45° FOV: 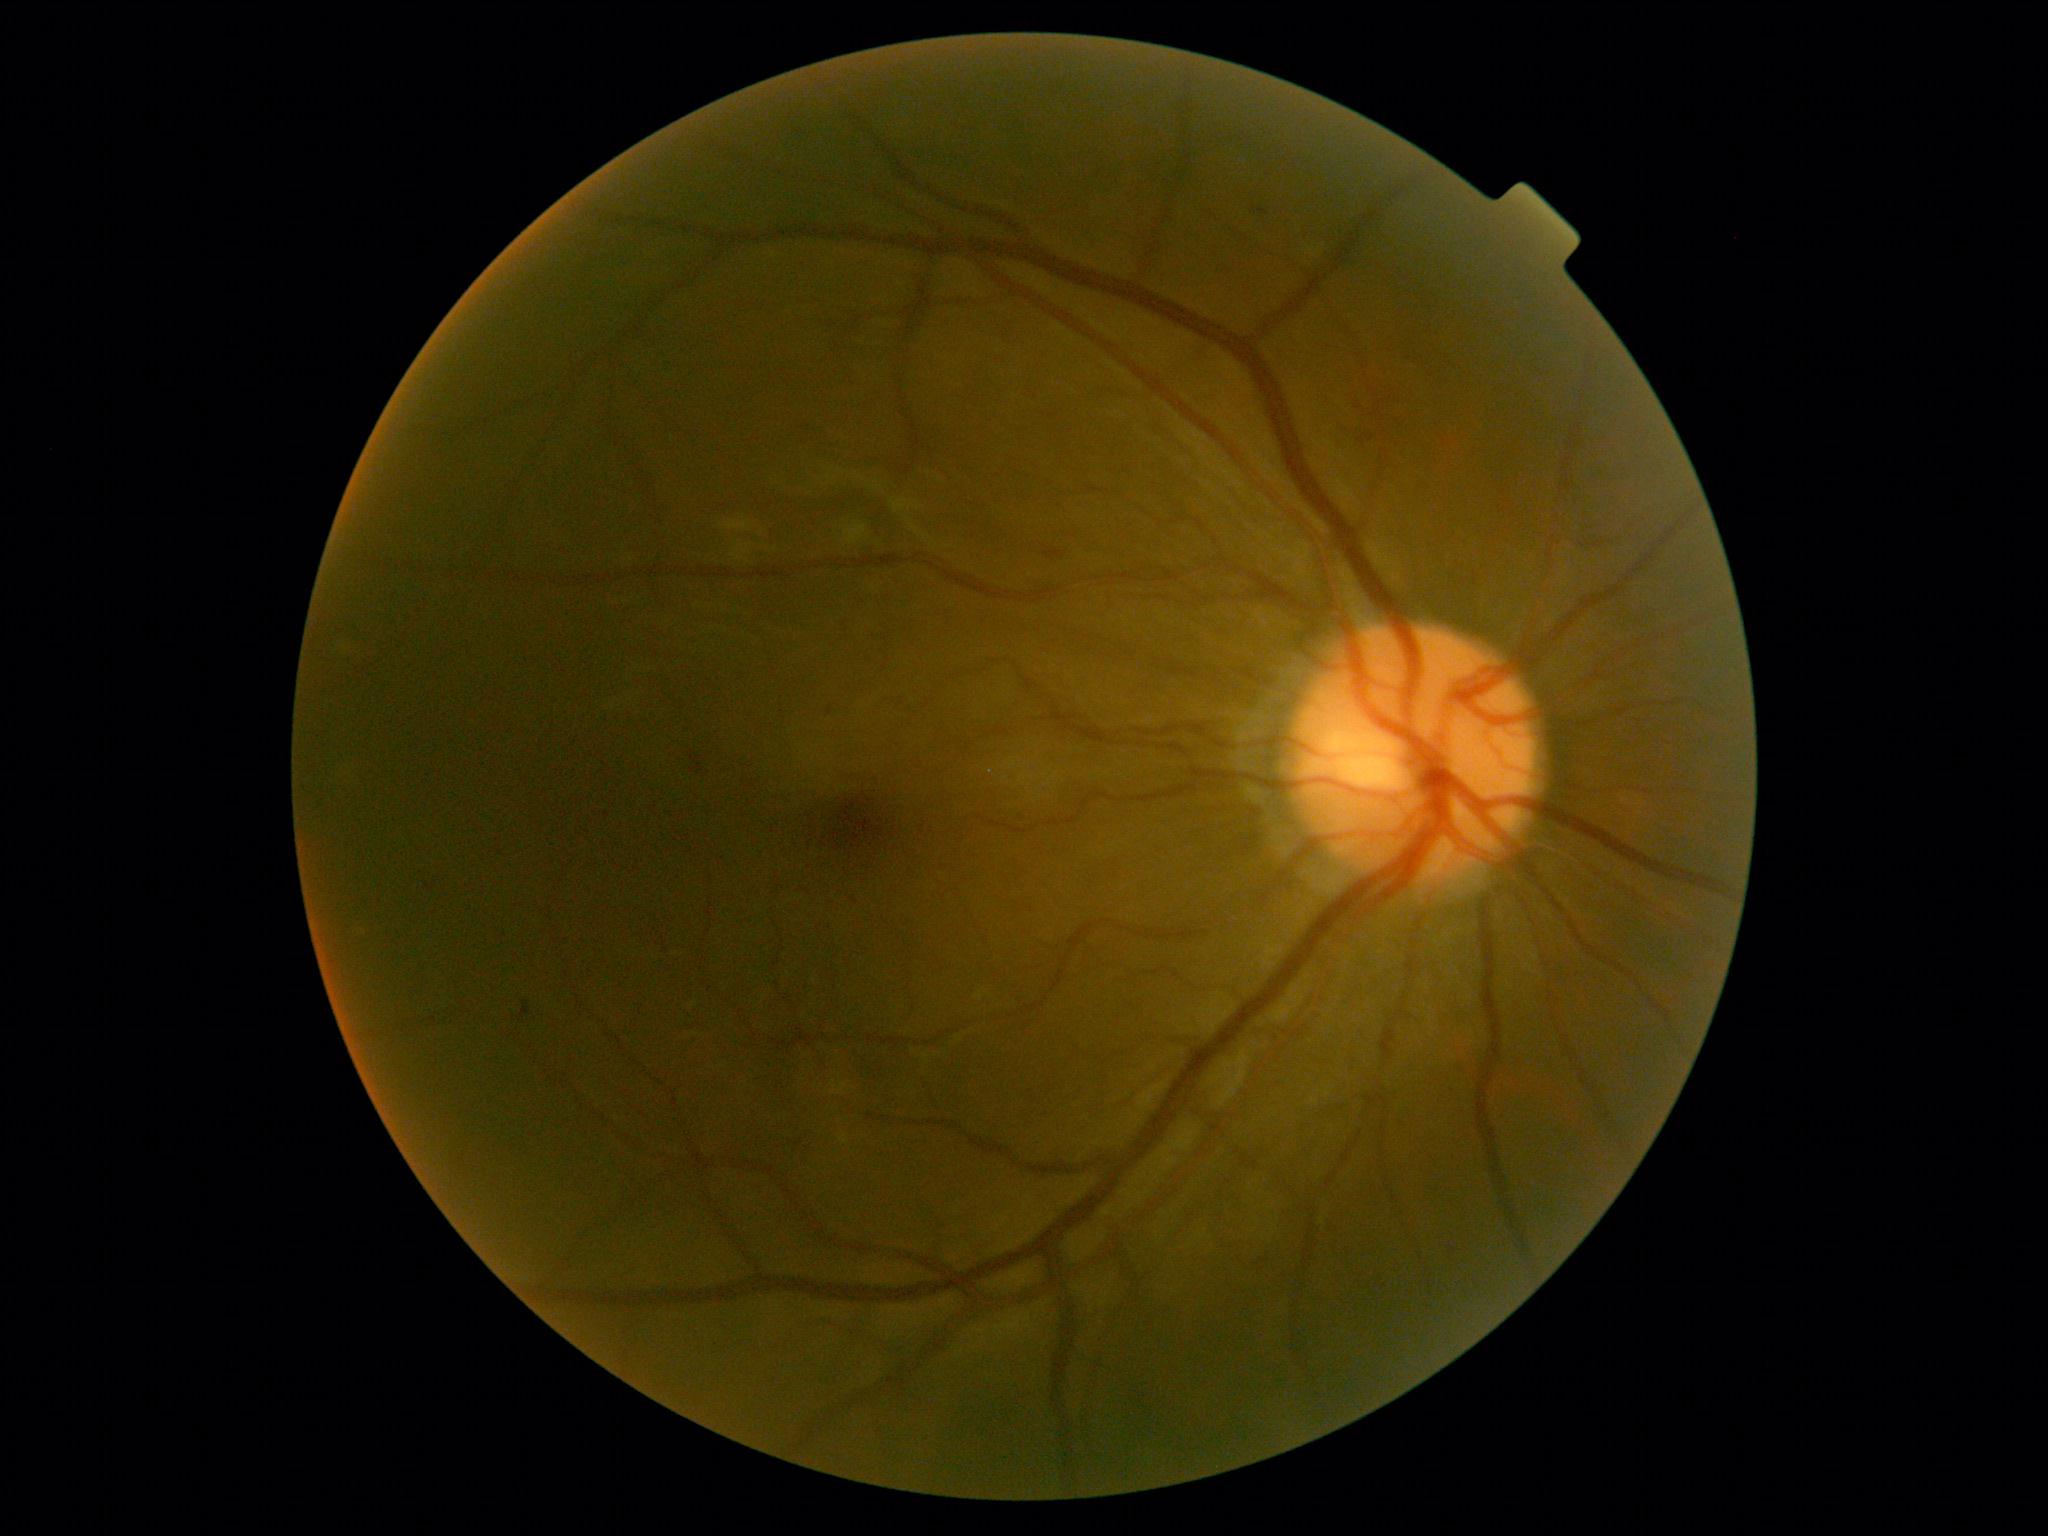
DR: mild NPDR (grade 1). Disease class: non-proliferative diabetic retinopathy.